Image size 240x240: 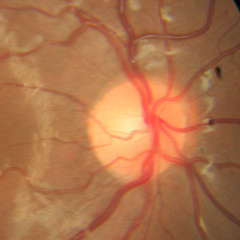
Q: Glaucoma assessment?
A: No glaucoma.